Retinal fundus photograph.
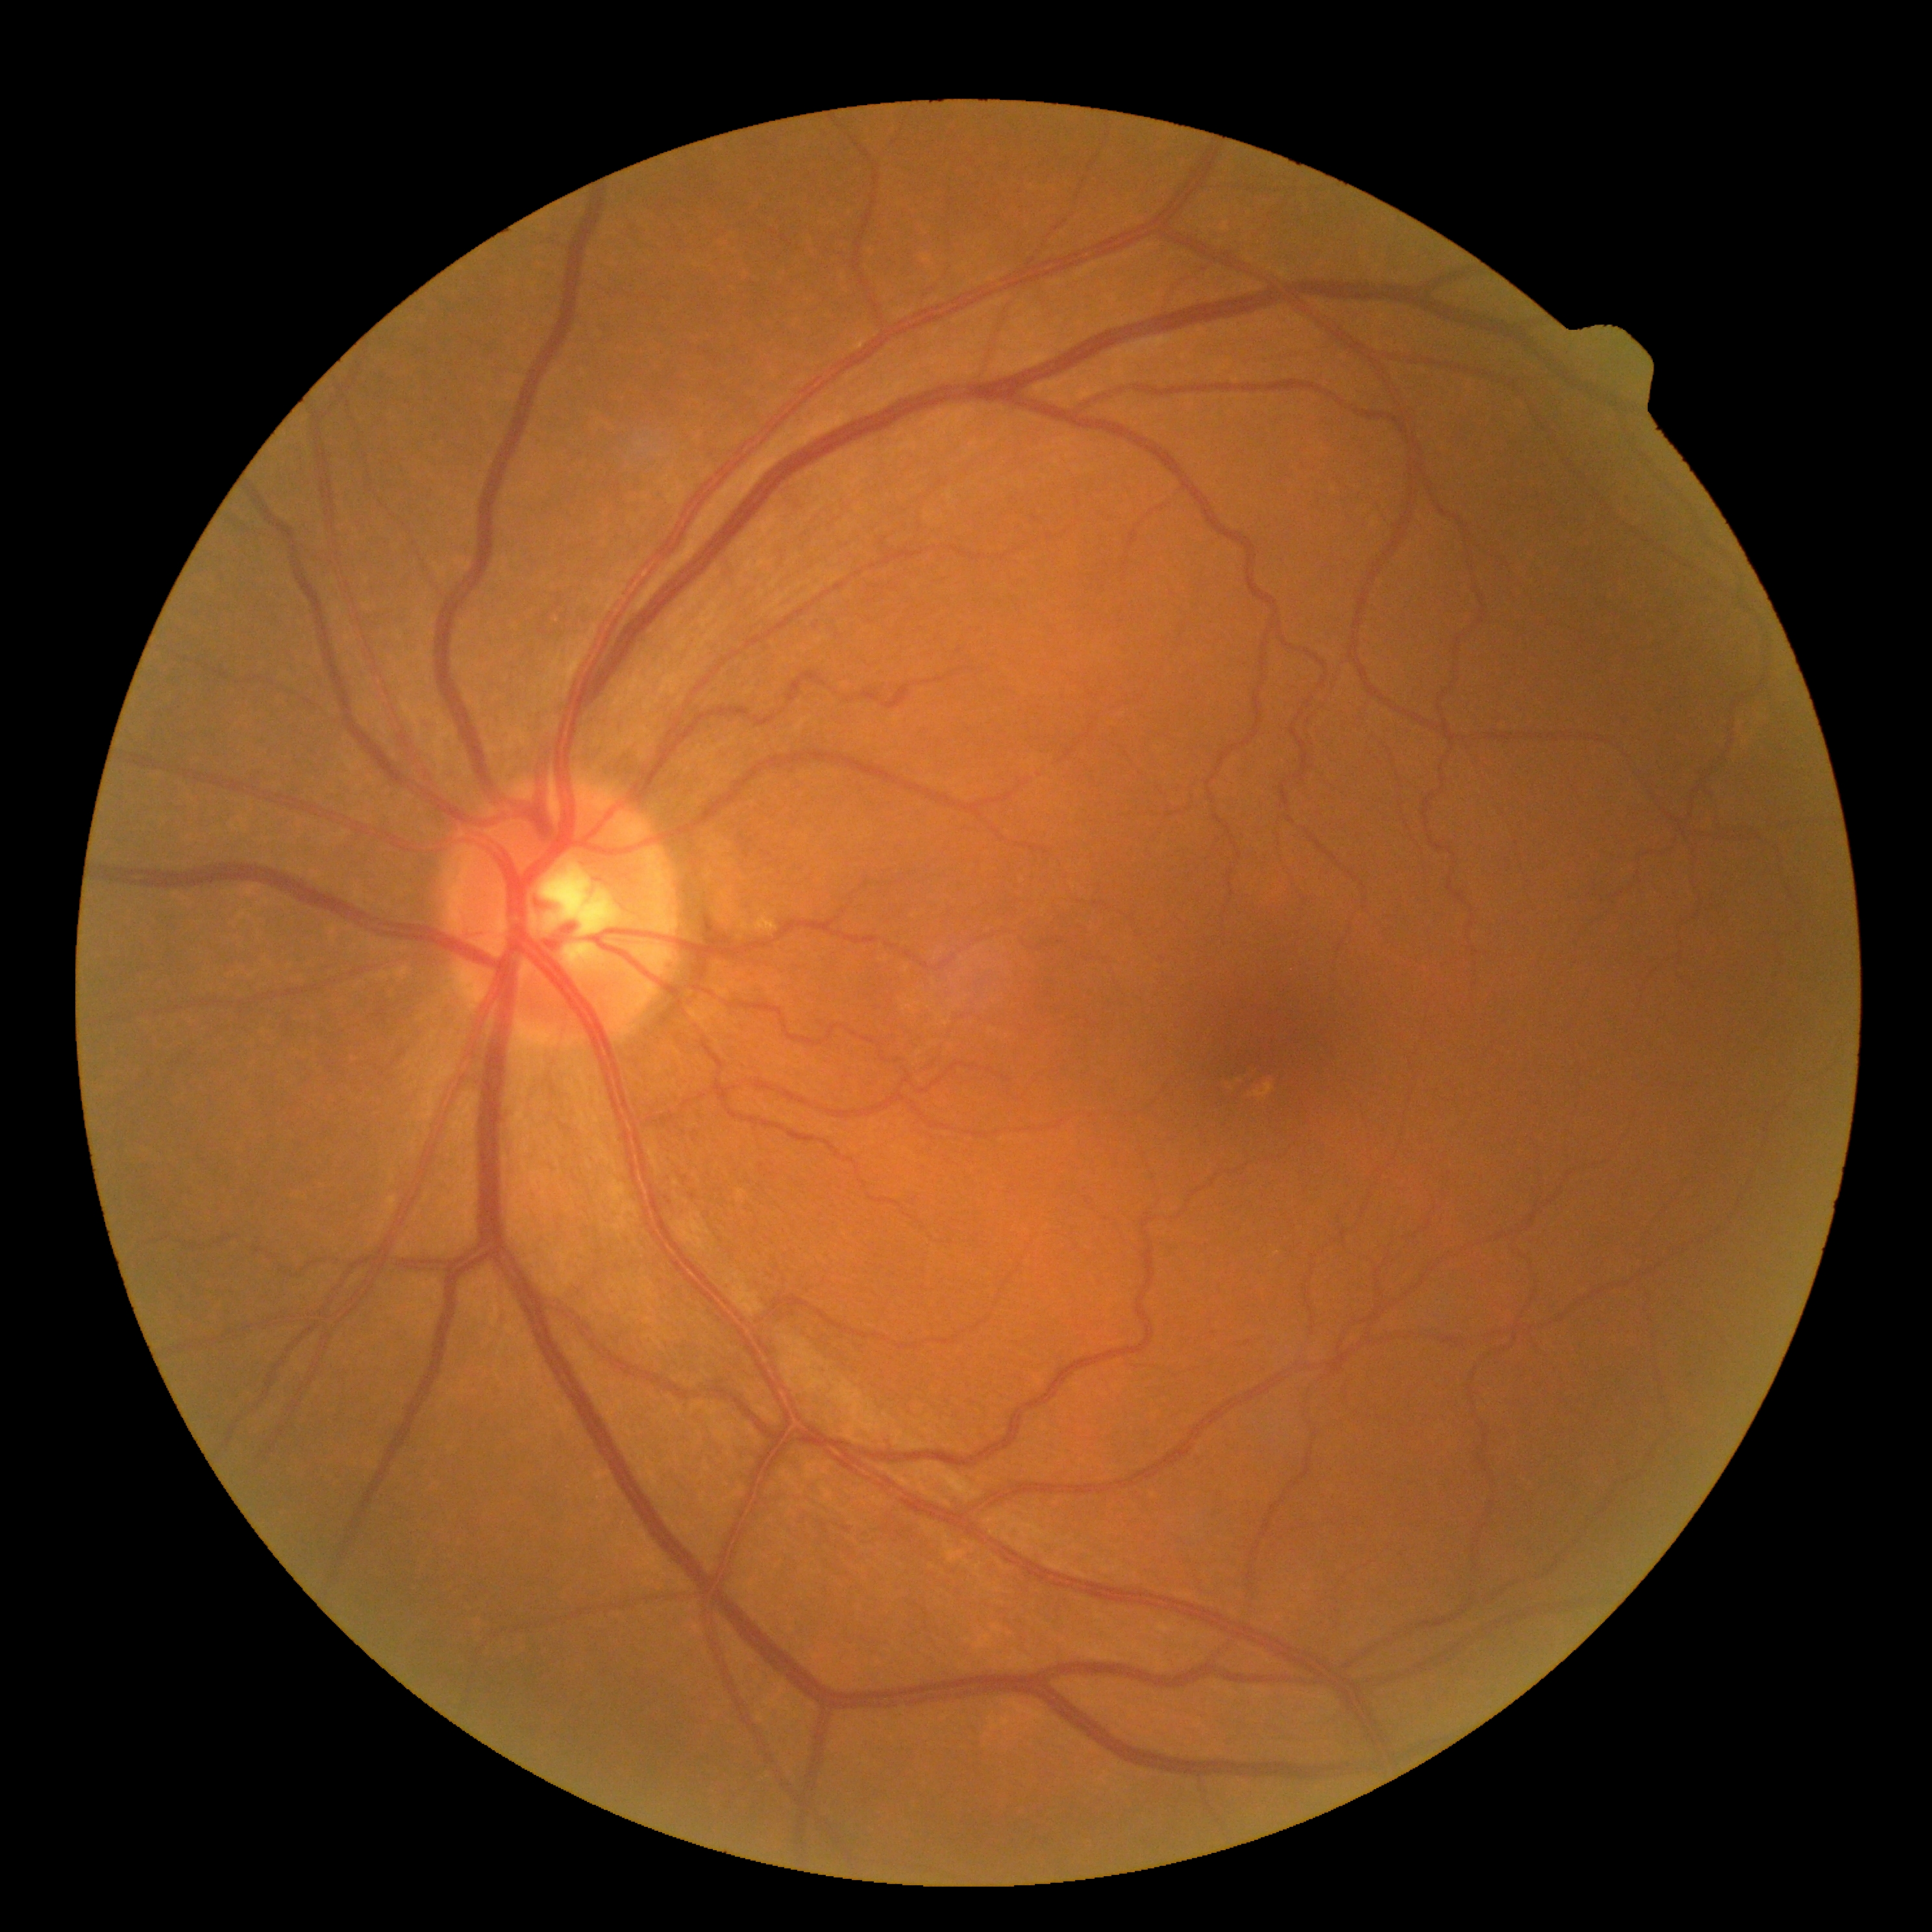 Findings:
• diabetic retinopathy severity: grade 0 (no apparent retinopathy)